45-degree field of view; image size 2352x1568; color fundus photograph
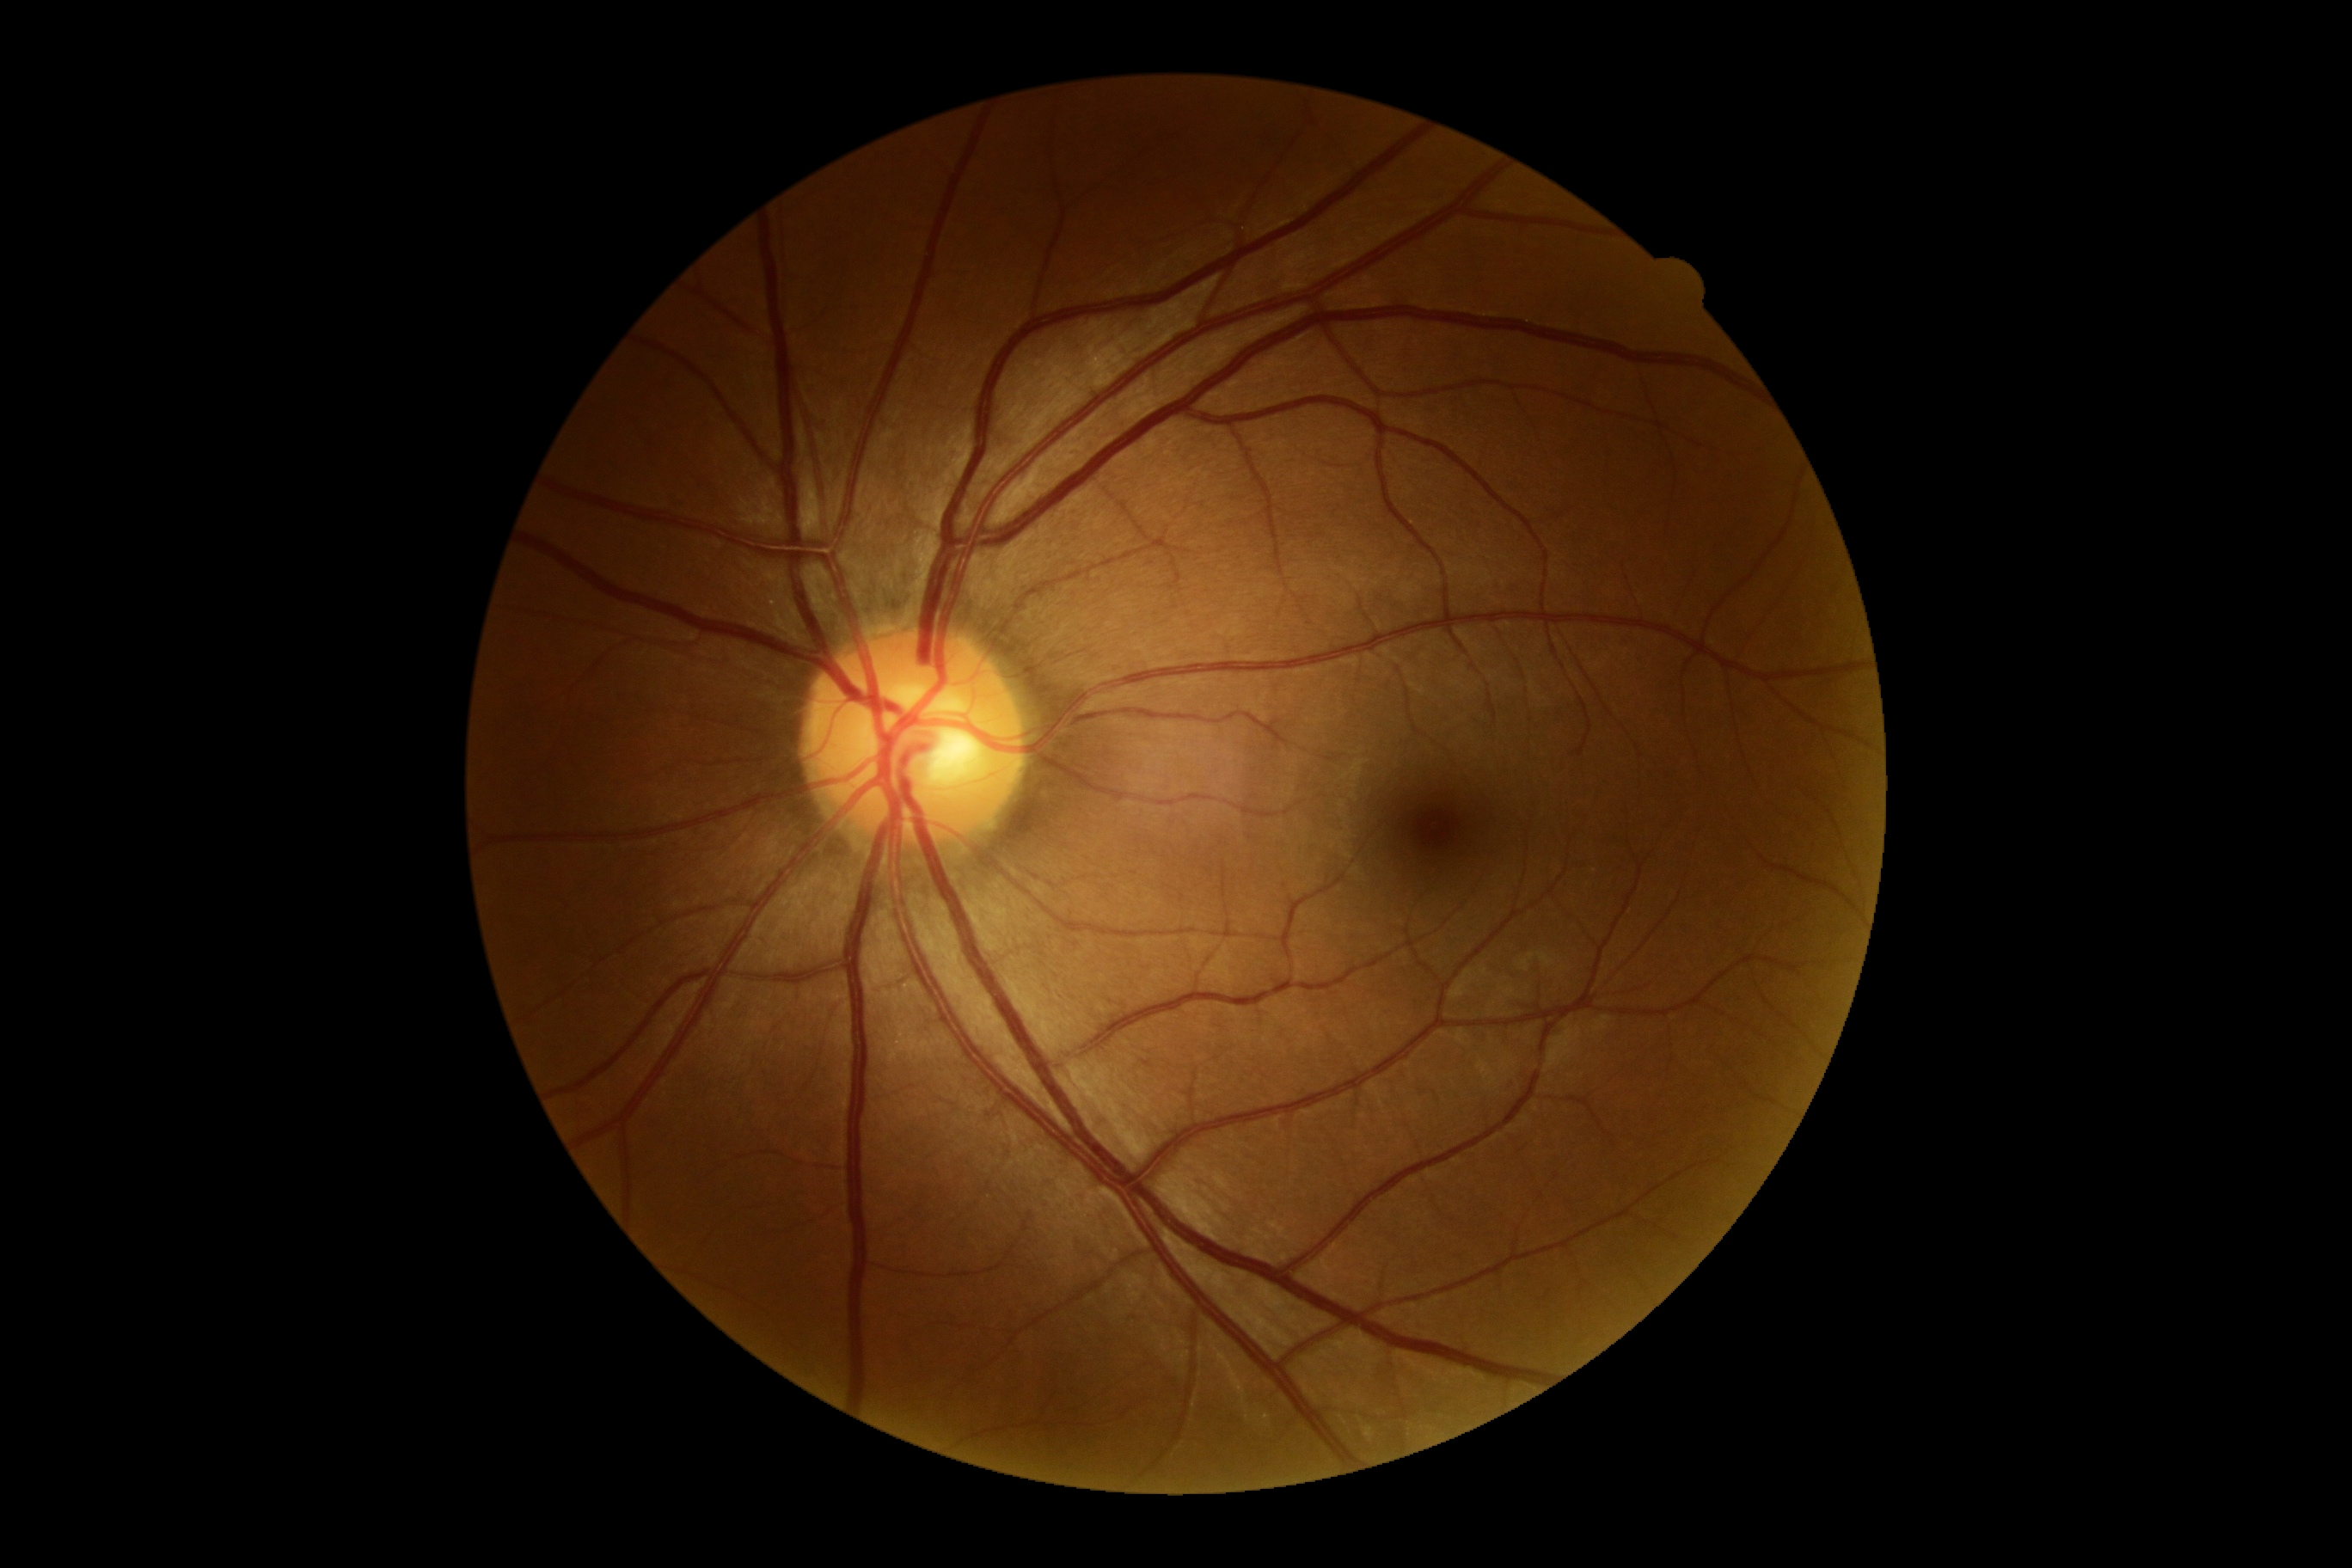
DR severity=grade 0 (no apparent retinopathy); DR impression=no apparent DR.